45° FOV; CFP.
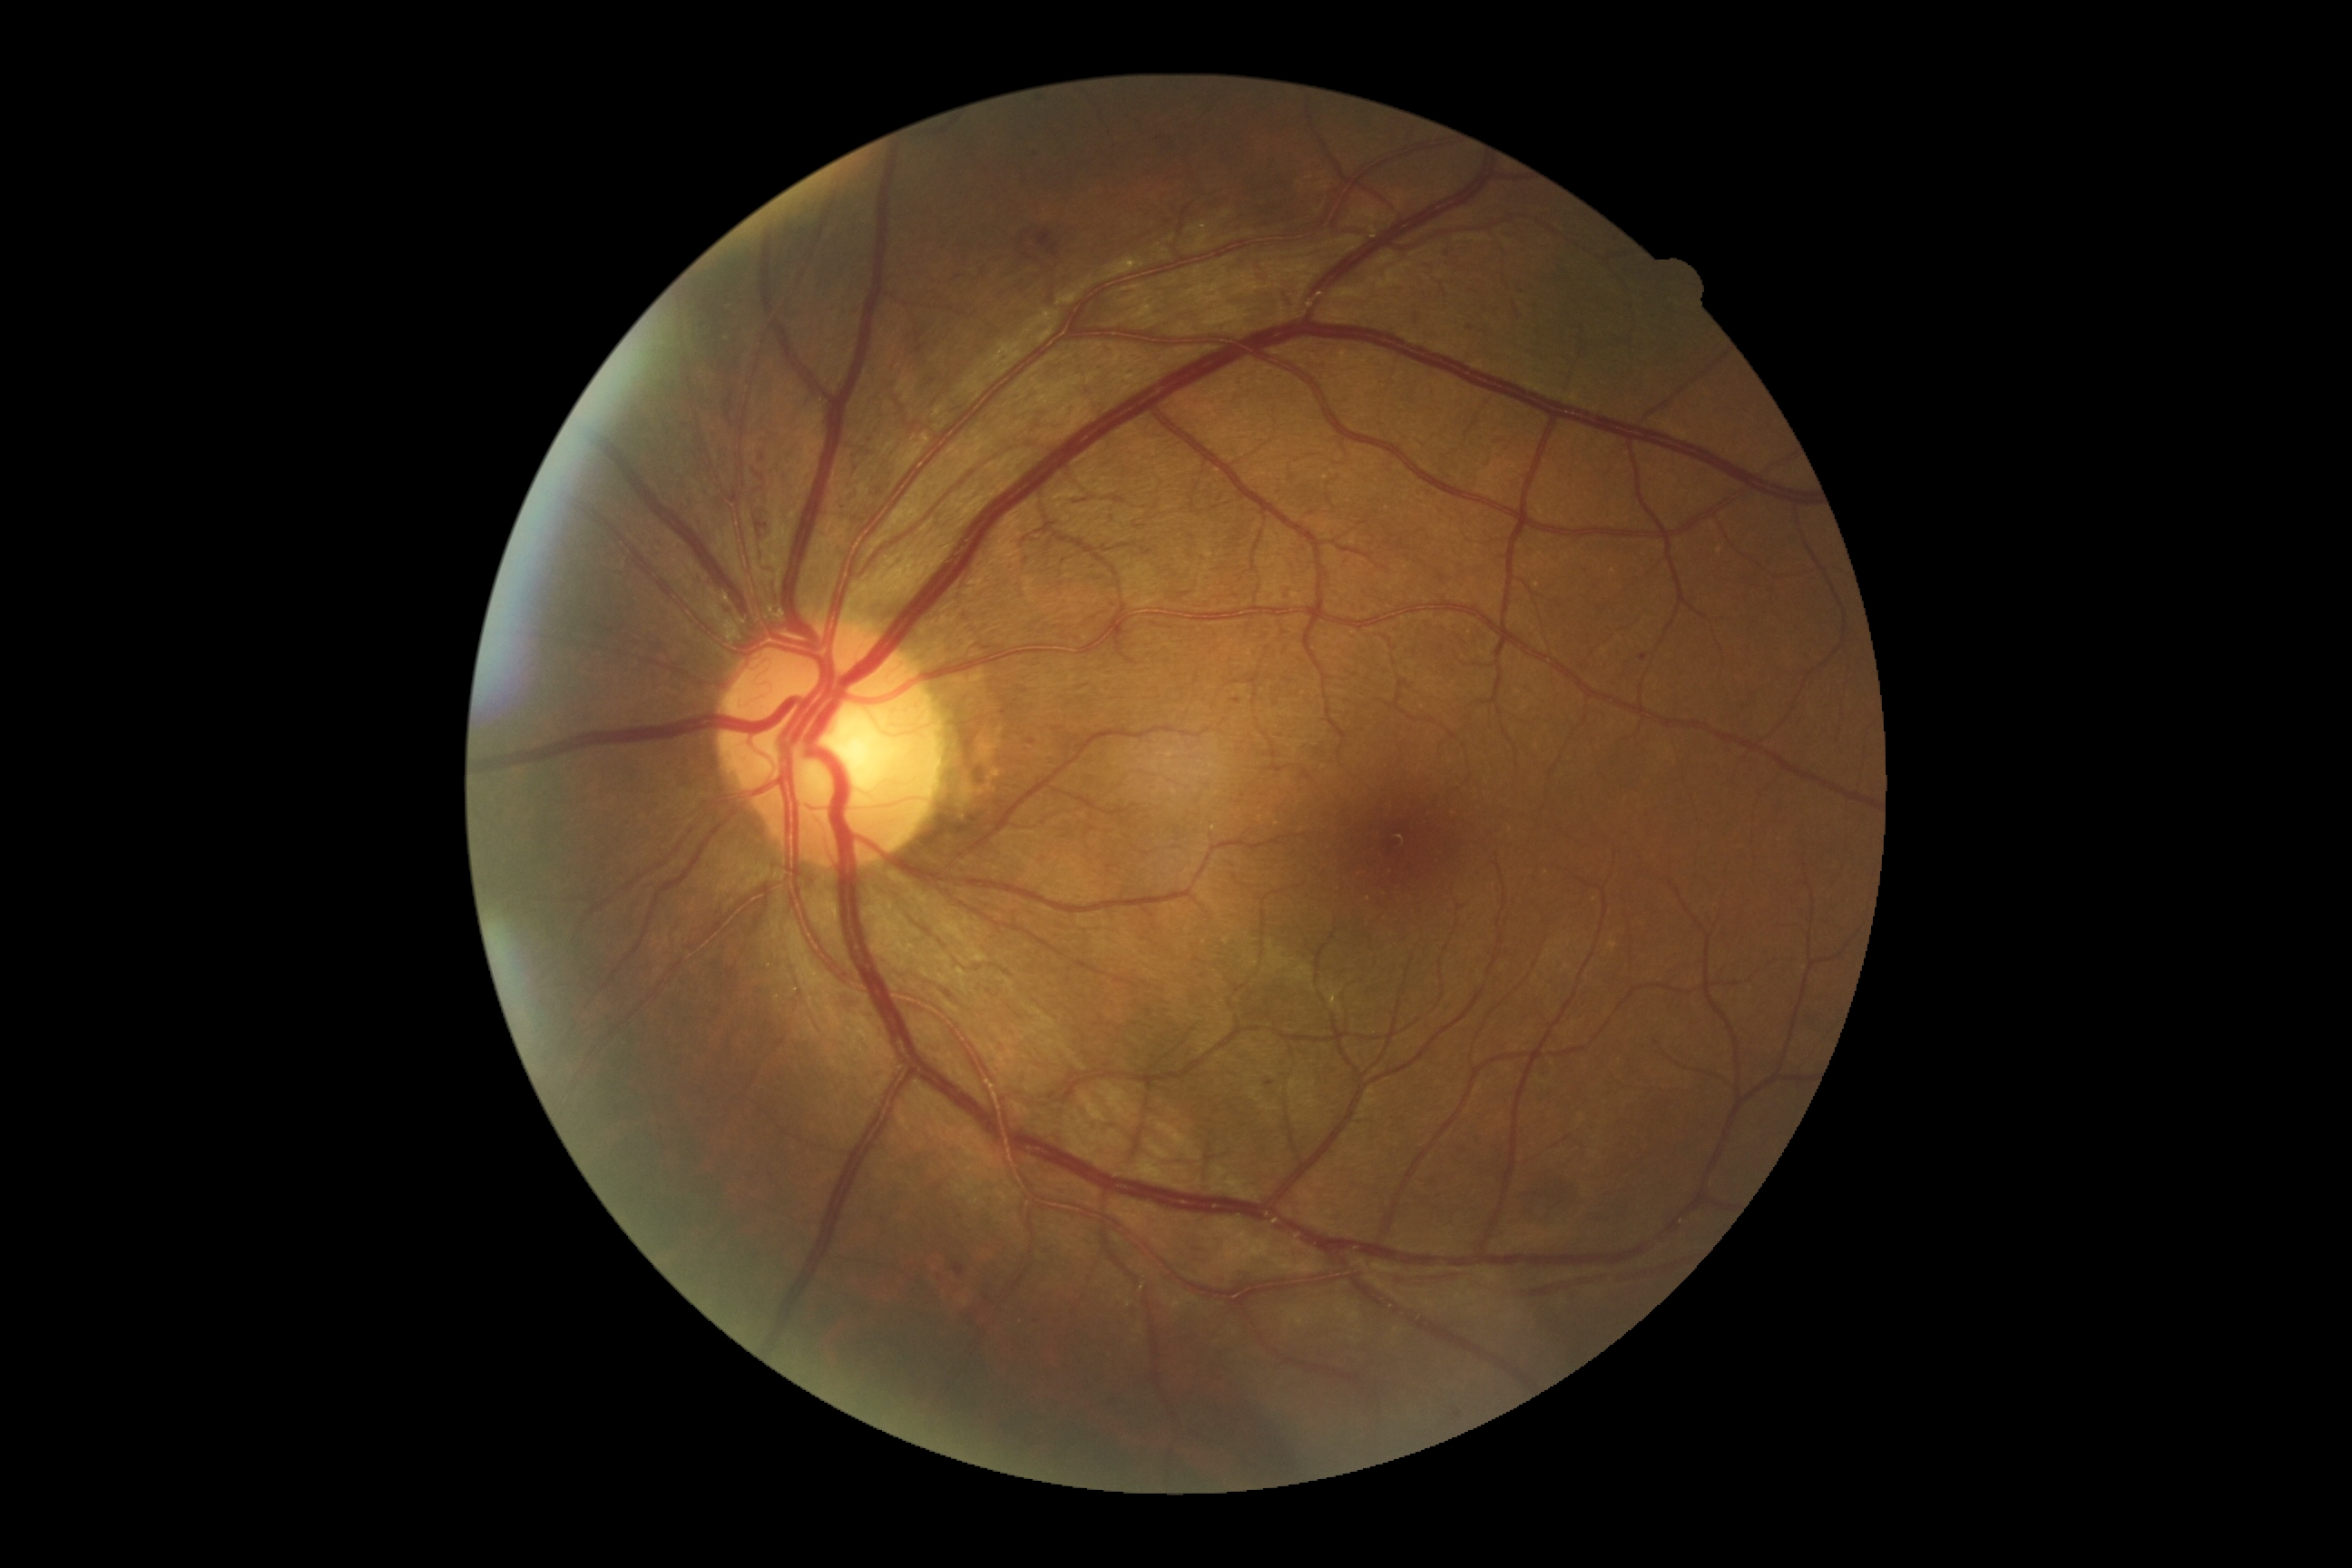
  dr_grade: 3
  dr_category: non-proliferative diabetic retinopathy